Retinal fundus photograph · 1659 x 2212 pixels: 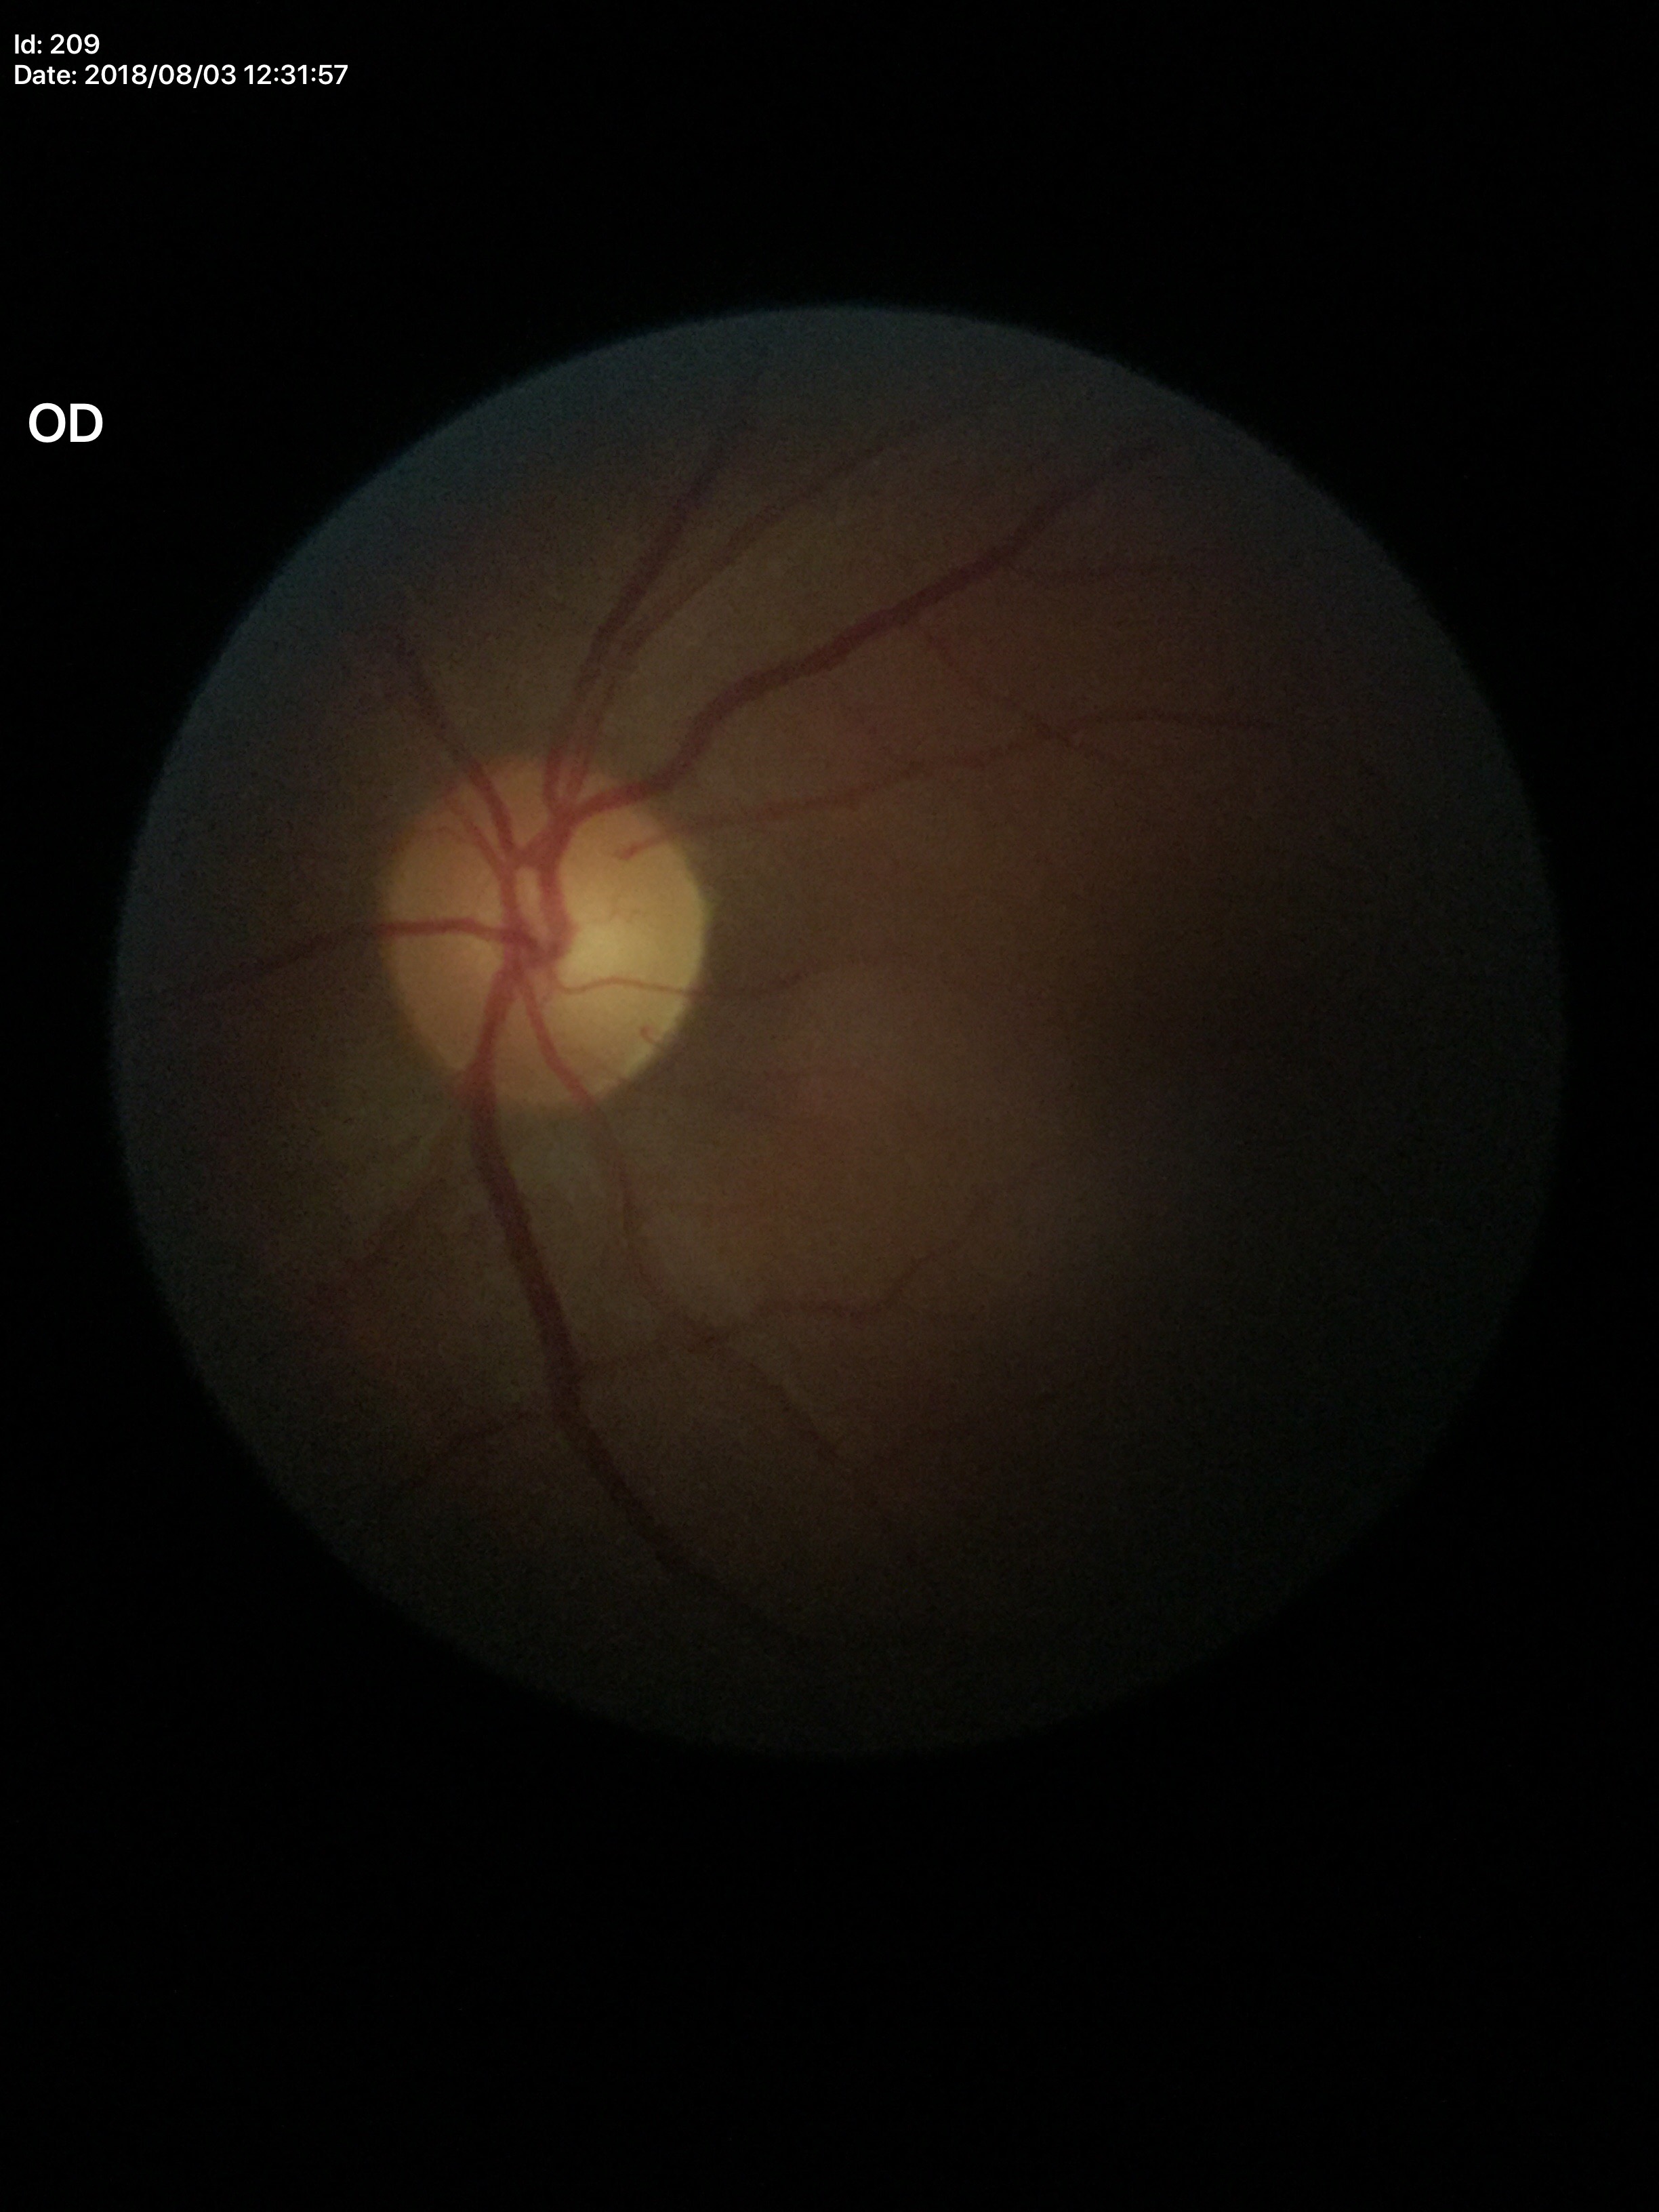 Negative for glaucoma suspicion.
Vertical cup-to-disc ratio (VCDR): 0.50.